CFP · image size 1659x2212:
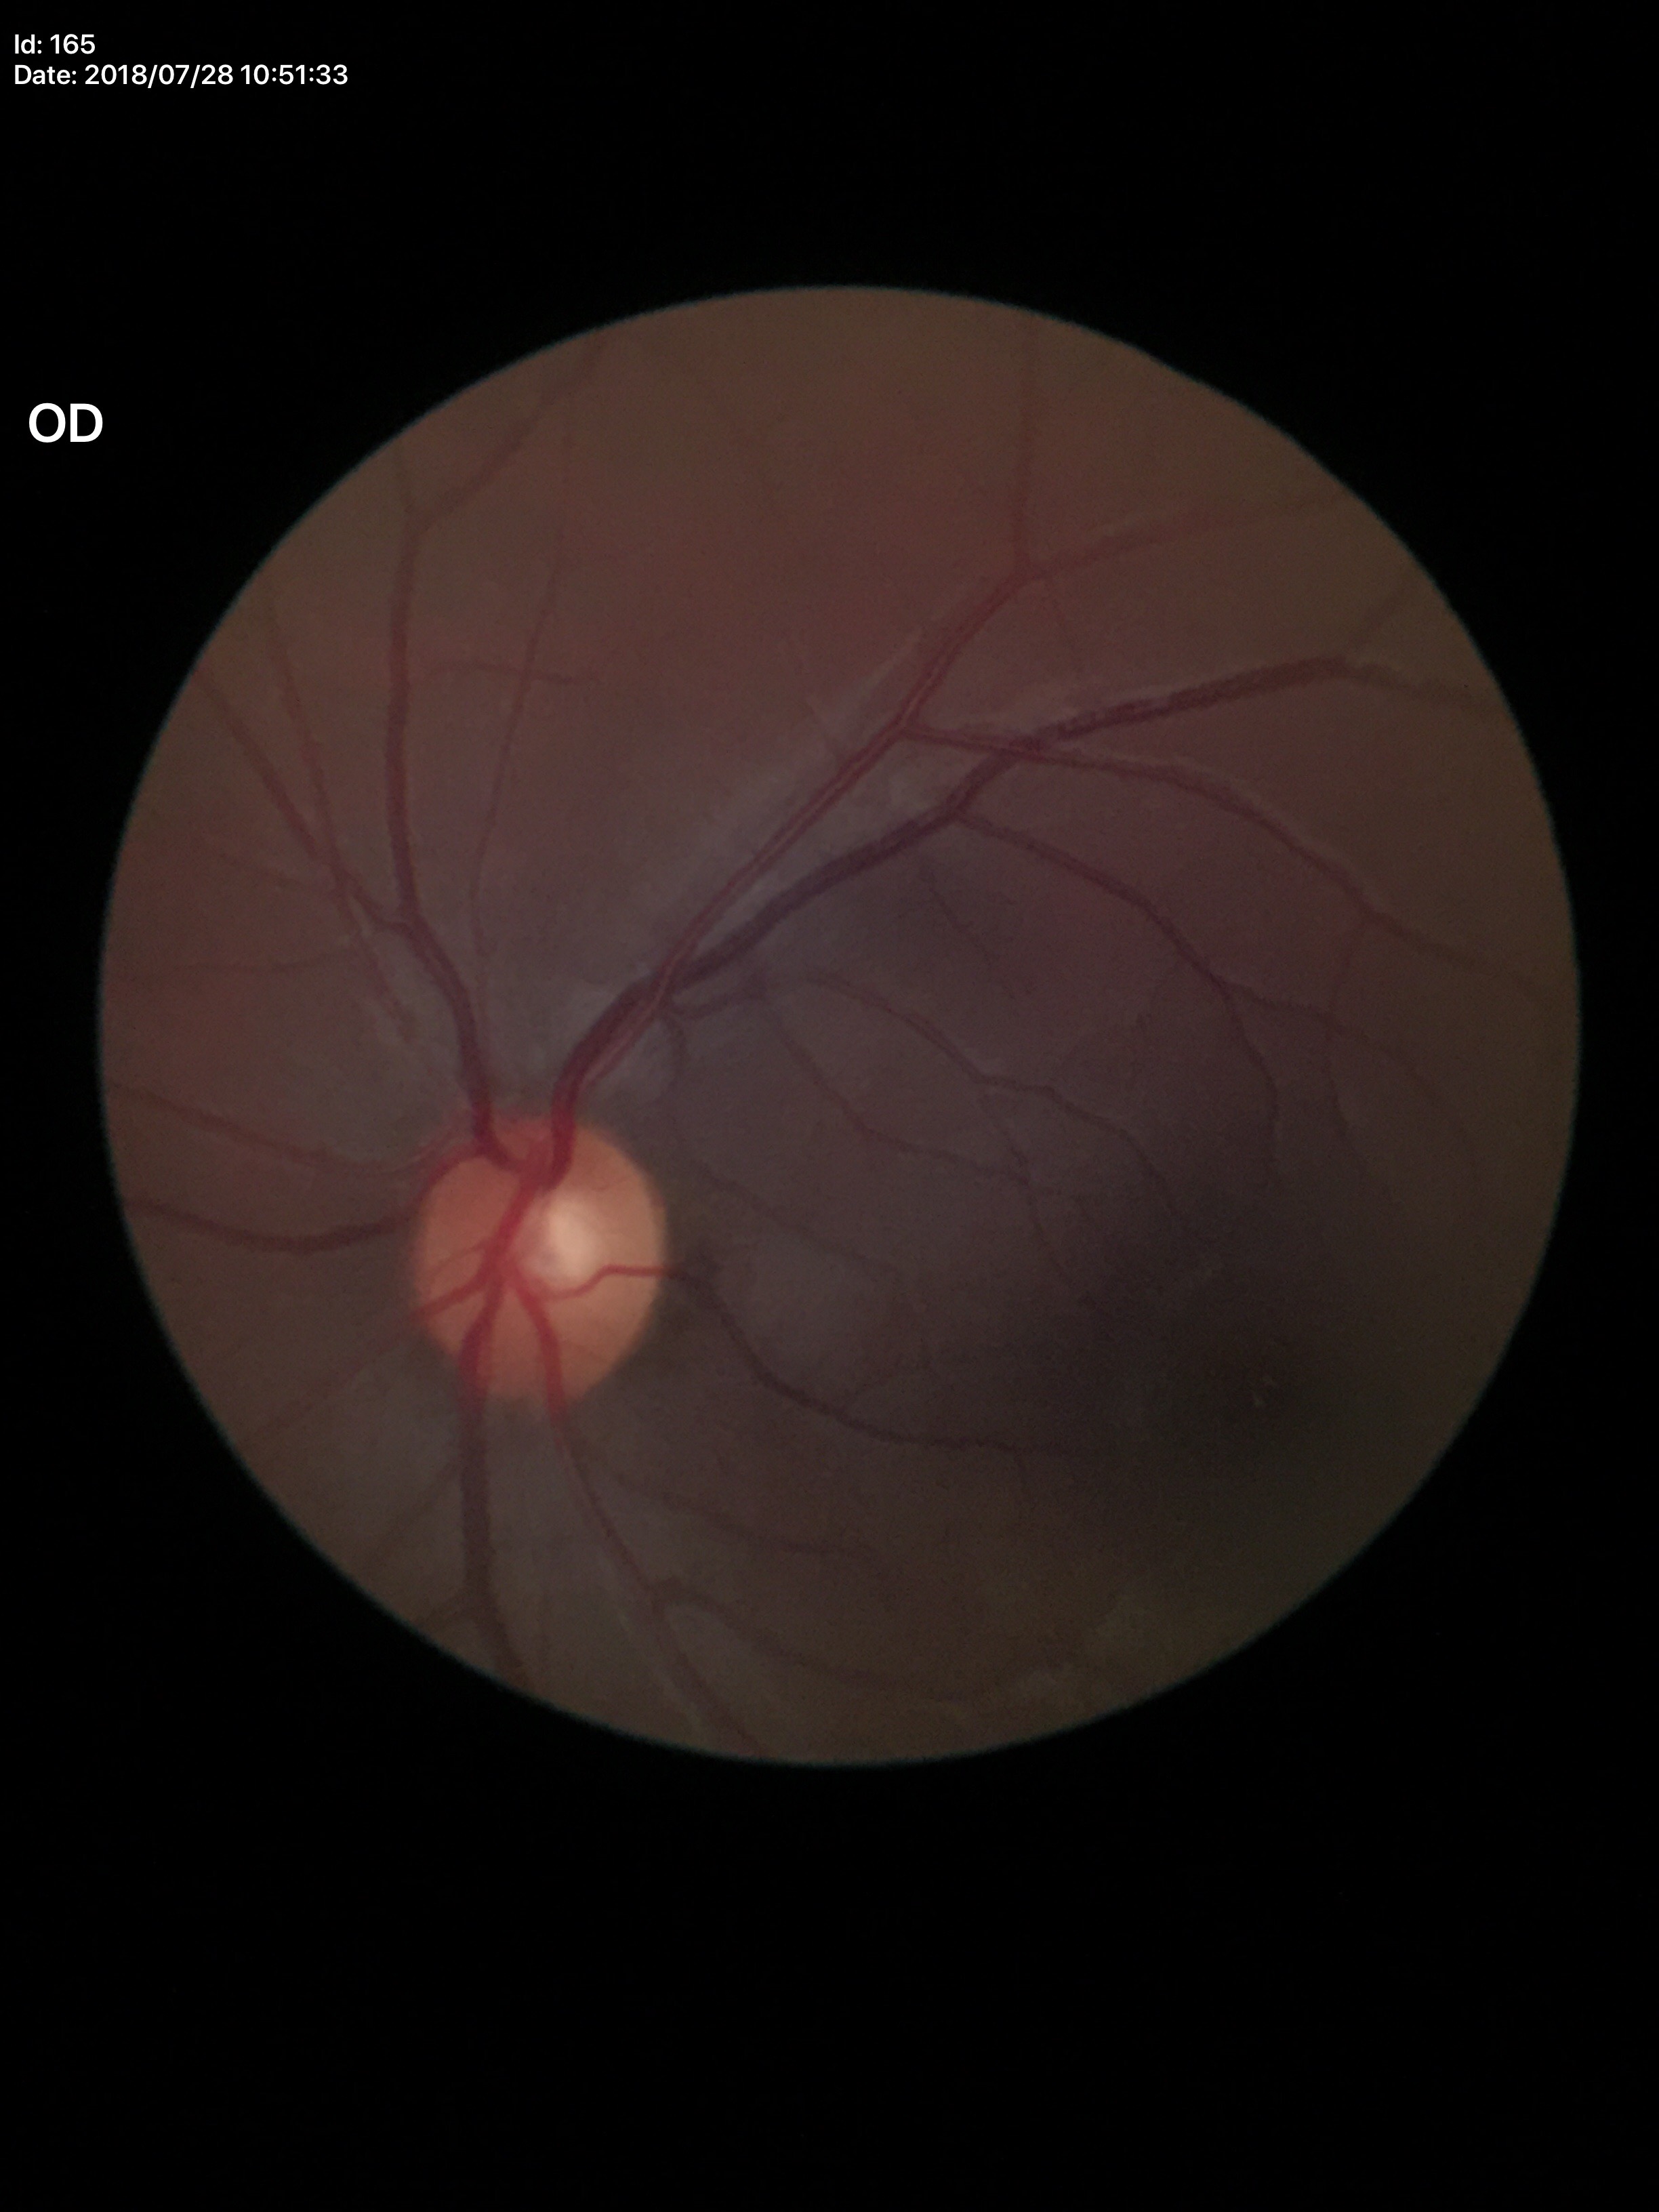
Glaucoma decision: no suspicious findings. Vertical cup-to-disc ratio (VCDR) is 0.48.